Wide-field contact fundus photograph of an infant.
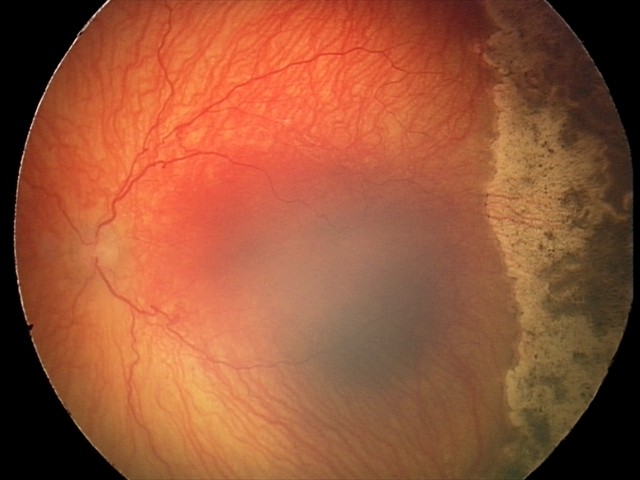

Diagnosis from this screening exam: aggressive retinopathy of prematurity.
With plus disease.